45° field of view.
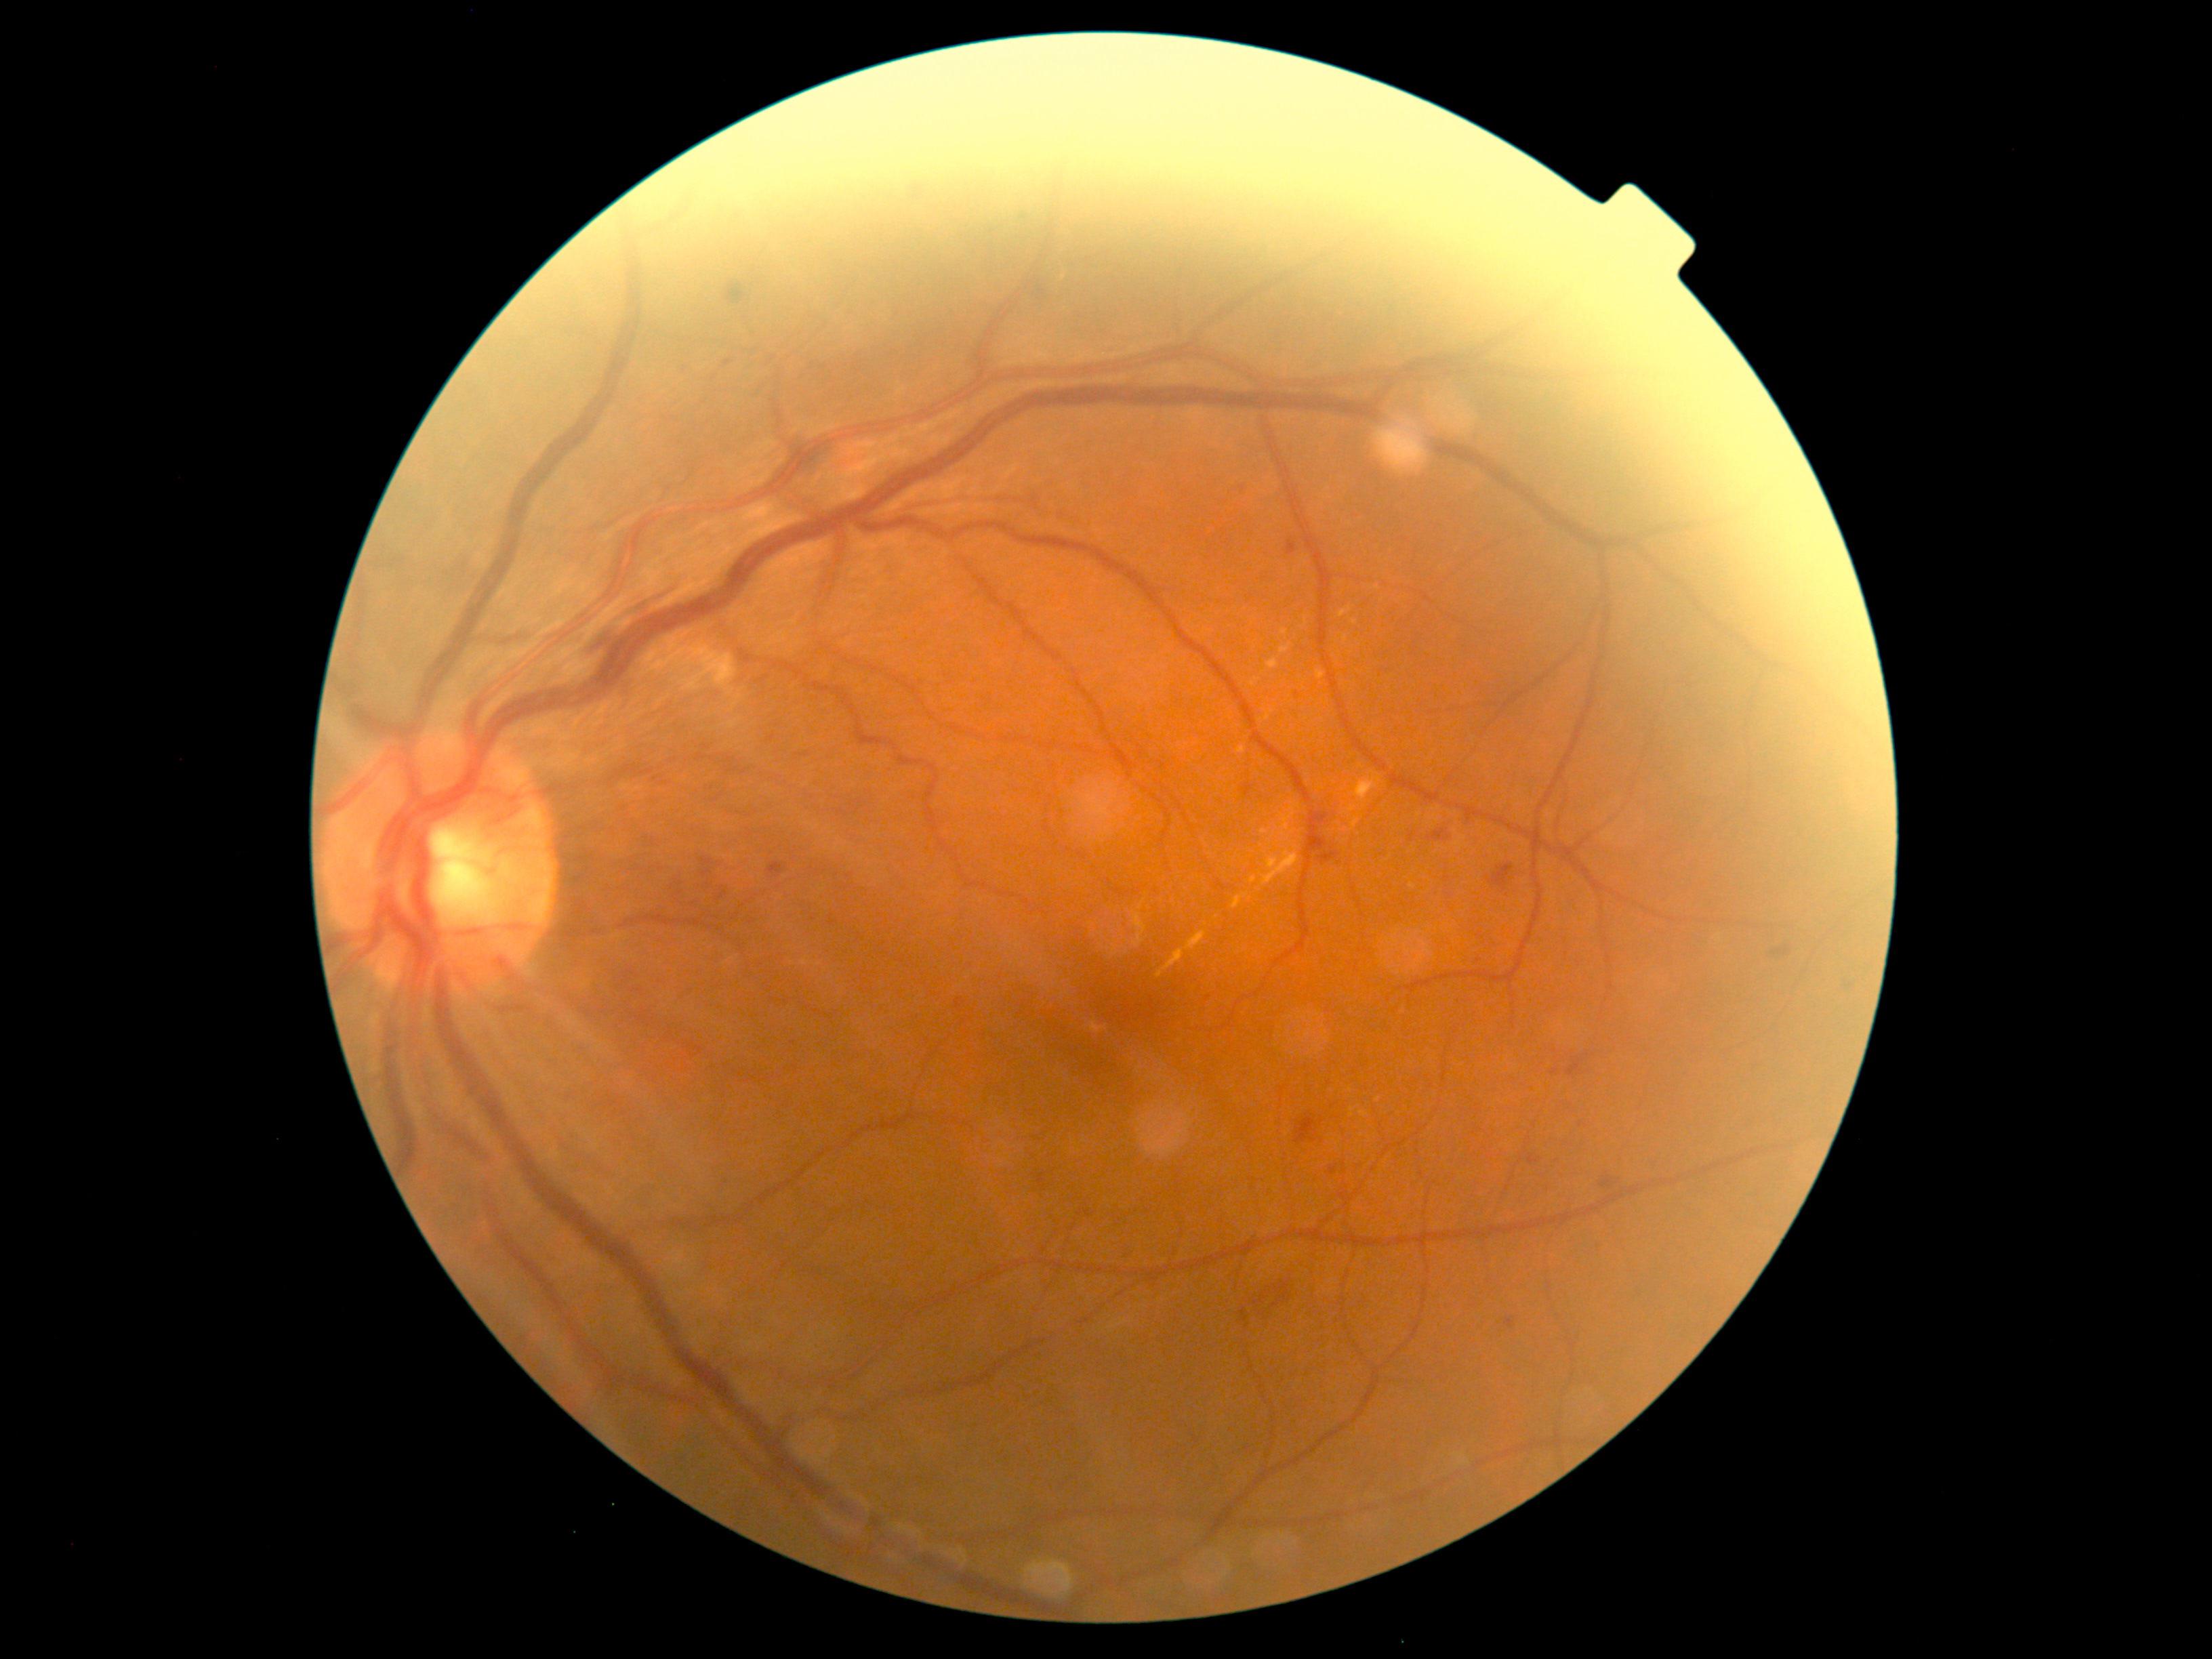
Diabetic retinopathy: grade 2 (moderate NPDR); non-proliferative diabetic retinopathy.
Hard exudates include box=[1233, 893, 1250, 910]; box=[1250, 678, 1261, 687]; box=[1279, 803, 1300, 837]; box=[1260, 851, 1299, 886]; box=[1360, 1112, 1370, 1118]; box=[1267, 658, 1279, 670]; box=[1282, 628, 1288, 636]; box=[1265, 710, 1275, 722].
Small hard exudates near 1378:1100; 1253:880; 1355:623.